45° field of view. NIDEK AFC-230: 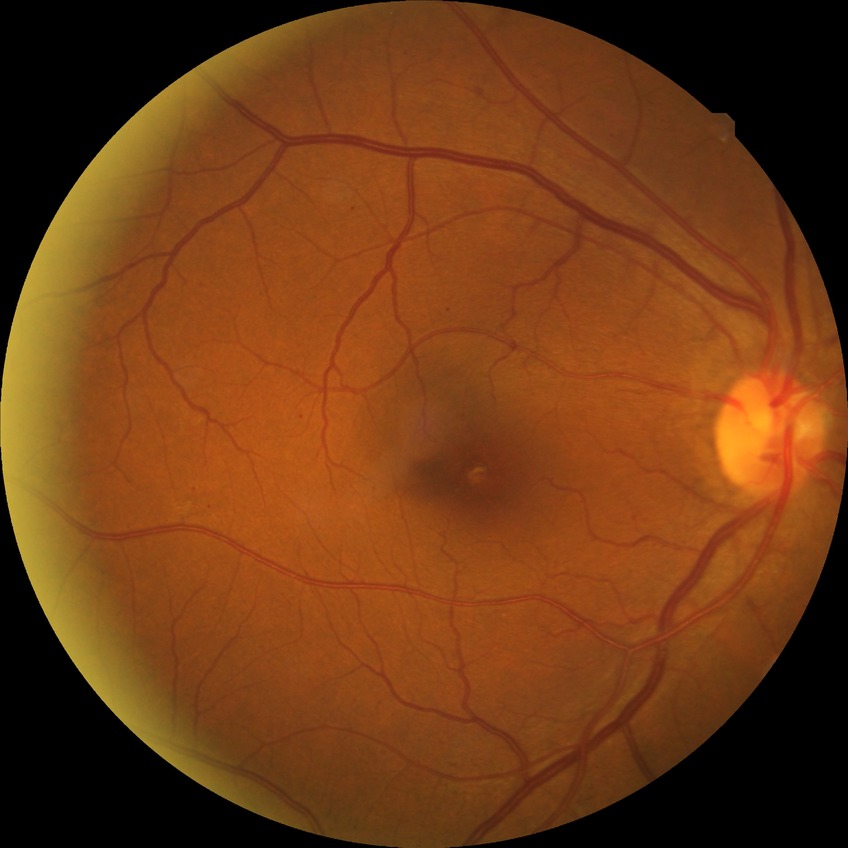

retinopathy stage: simple diabetic retinopathy.